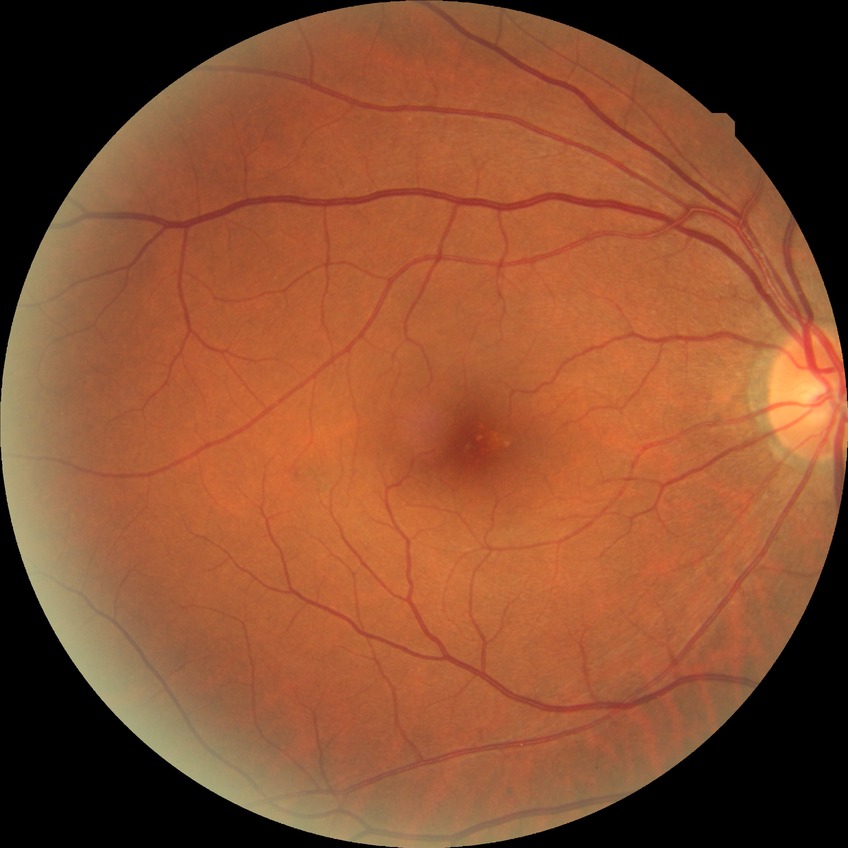
Diabetic retinopathy (DR) is NDR (no diabetic retinopathy).